Retinal fundus photograph. 45° FOV:
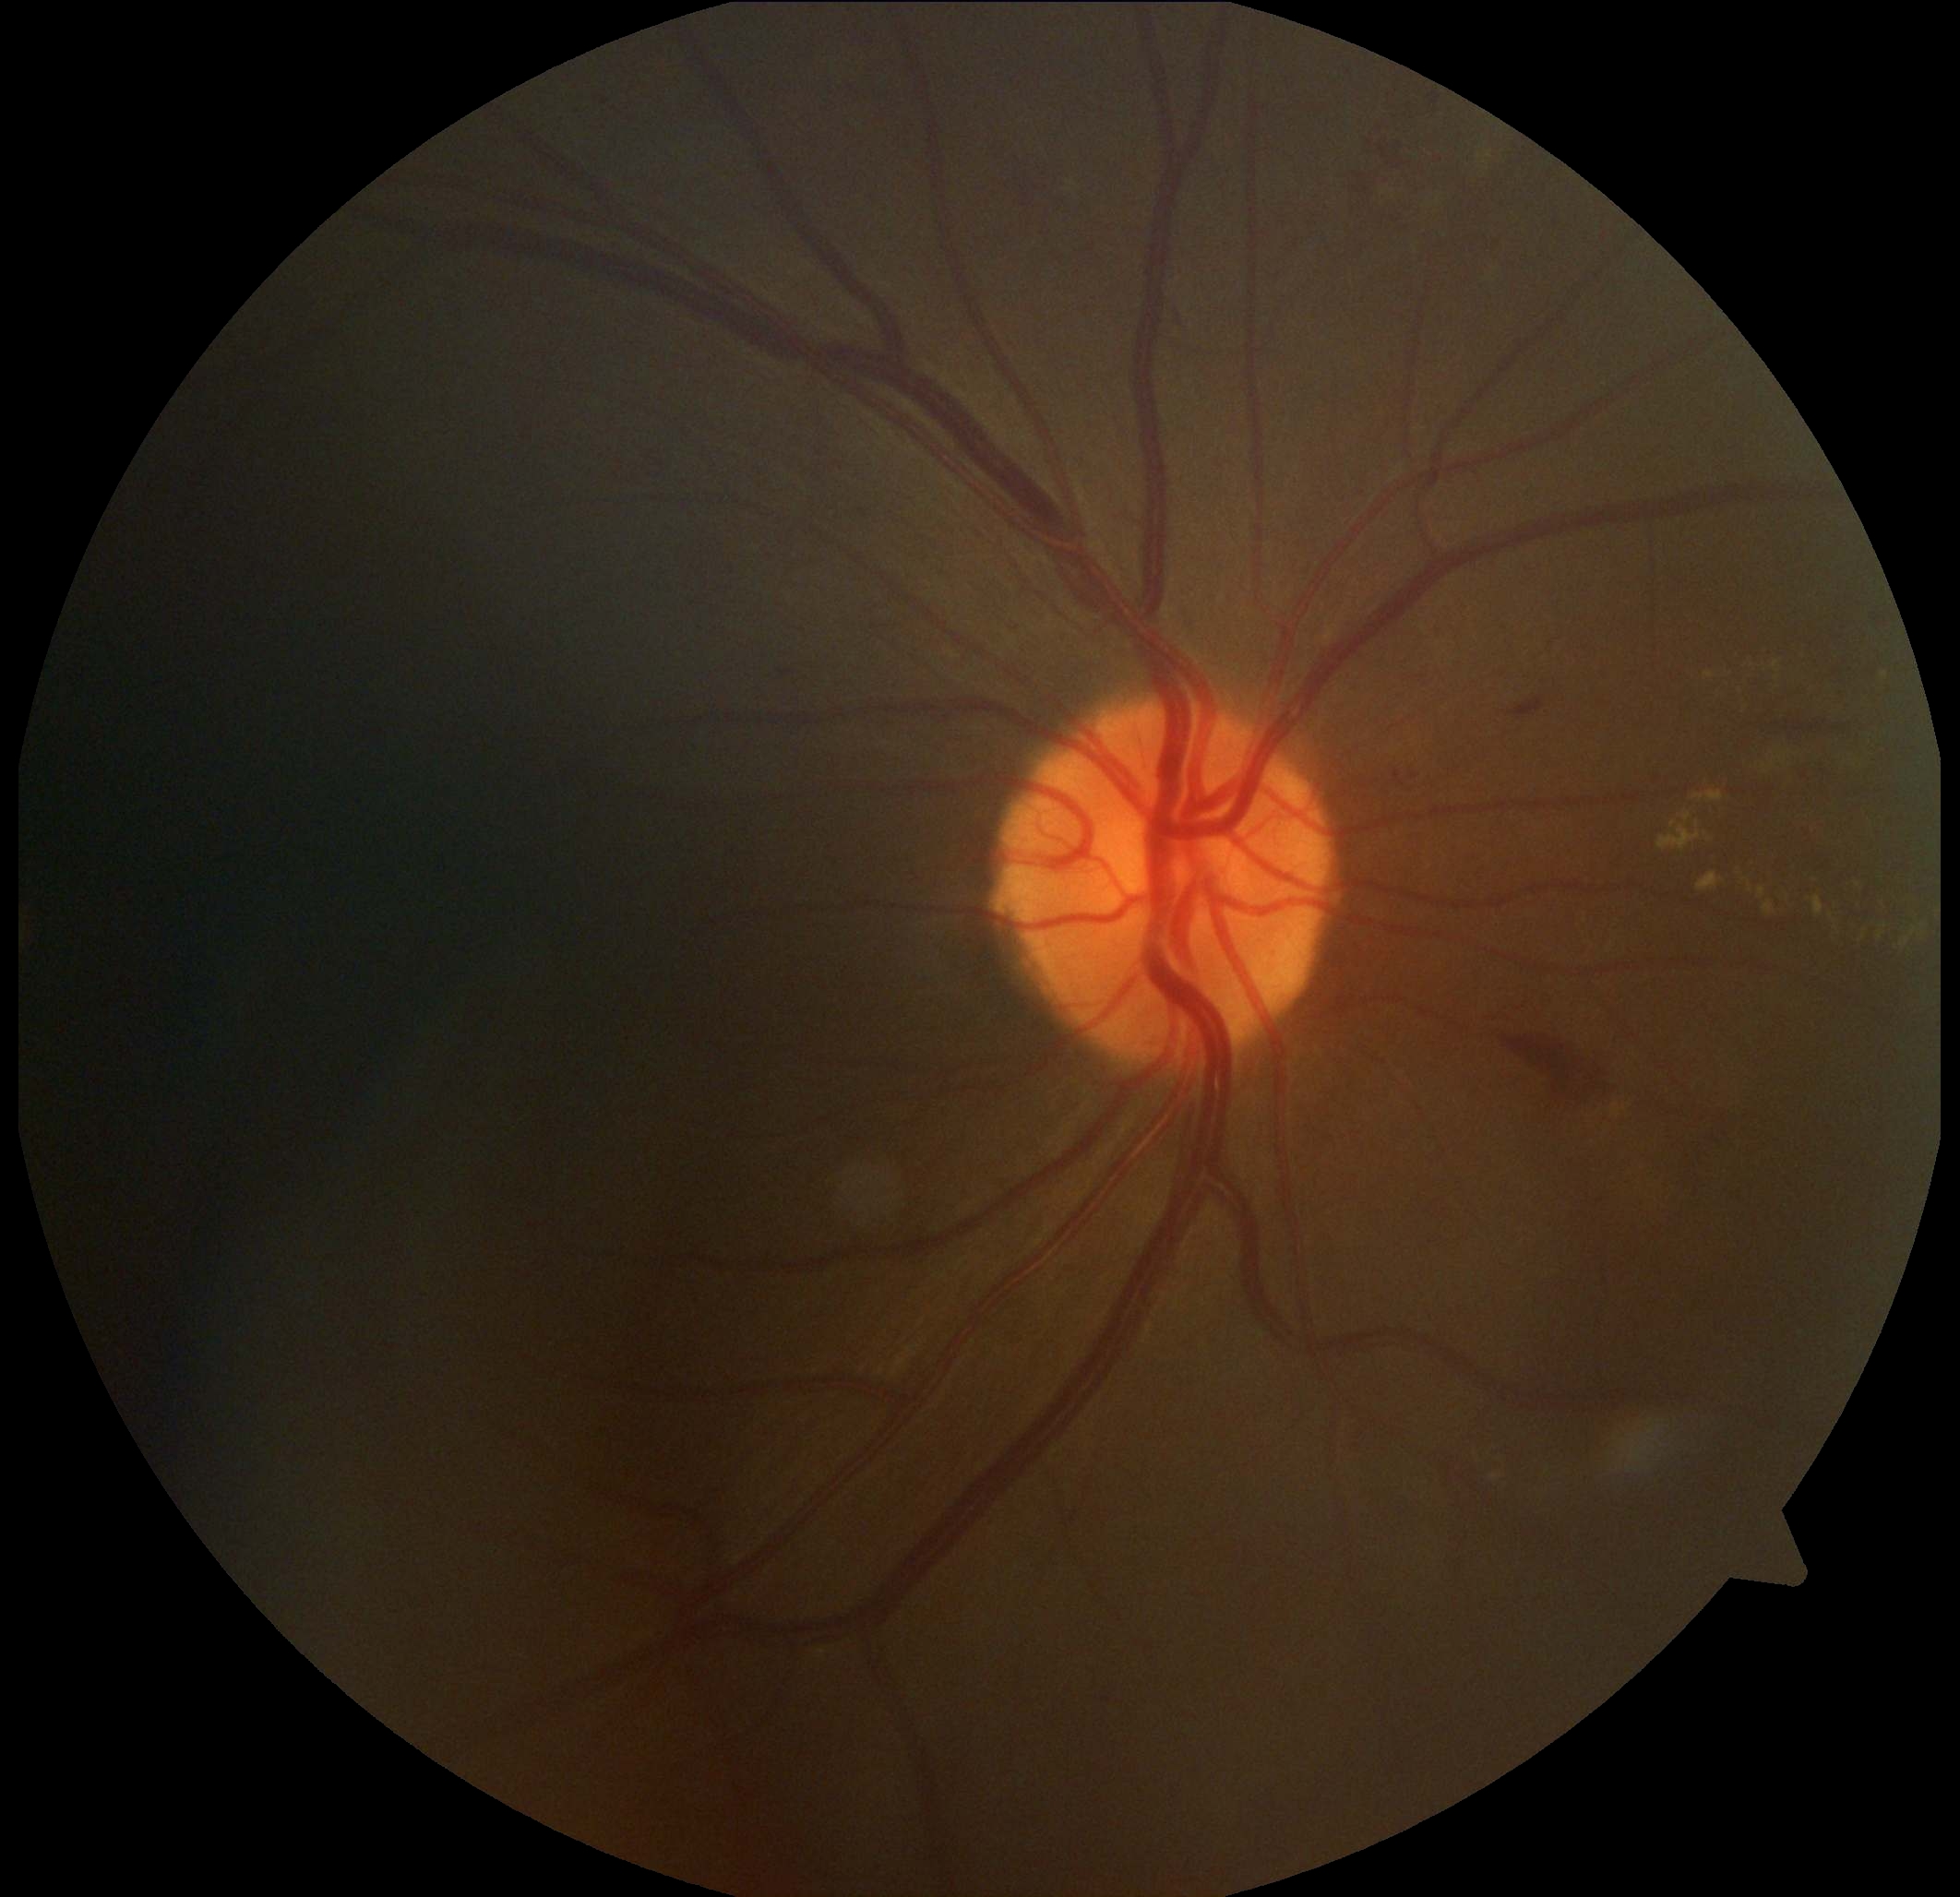
Diabetic retinopathy is 2/4
hard exudates = (1739, 655, 1783, 693), (1471, 1439, 1513, 1489), (1653, 730, 1945, 960), (1875, 670, 1888, 686)
Additional small hard exudates near [1710, 676]
hemorrhages = (1350, 171, 1381, 196), (1496, 1026, 1615, 1110), (602, 99, 610, 106), (1751, 722, 1869, 737), (1869, 614, 1888, 630), (860, 509, 868, 518), (780, 670, 794, 676), (998, 614, 1022, 638), (1366, 133, 1414, 173), (1599, 670, 1615, 684), (1385, 758, 1423, 793), (1425, 87, 1452, 110), (1509, 697, 1546, 720), (1417, 676, 1425, 682), (1170, 303, 1186, 330), (1799, 764, 1833, 785)
microaneurysms = absent
soft exudates = absent